Non-mydriatic fundus camera, optic disc-centered crop.
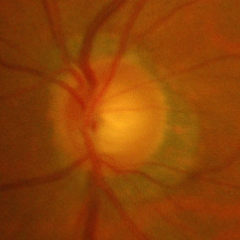 This fundus photograph shows advanced glaucomatous optic neuropathy.